848 x 848 pixels; color fundus photograph — 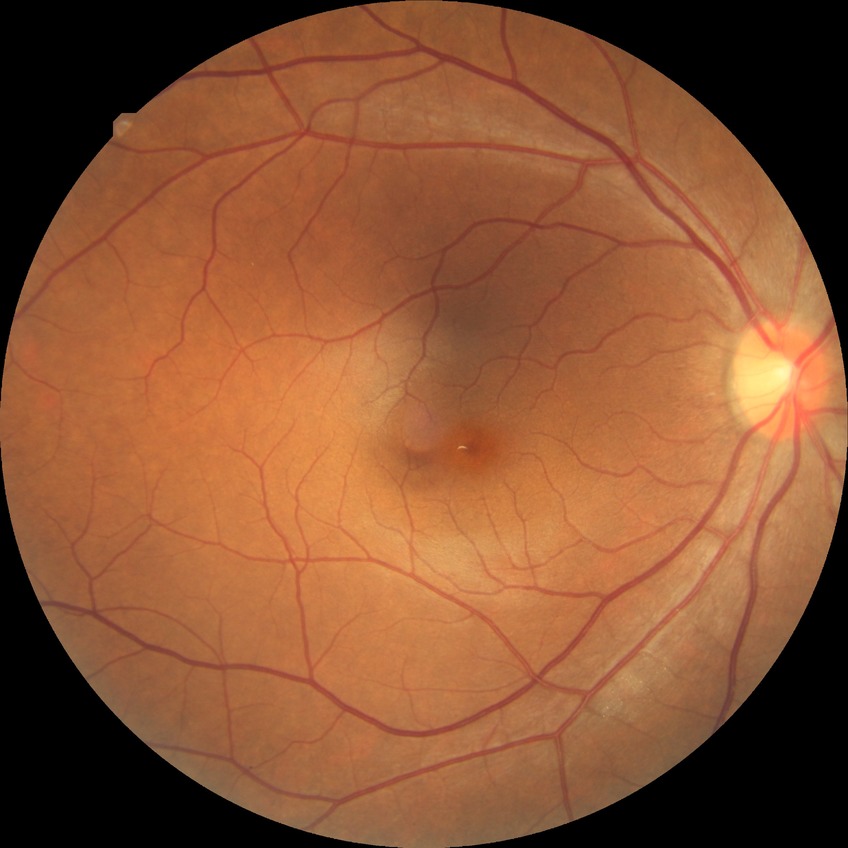
  davis_grade: no diabetic retinopathy